45° field of view.
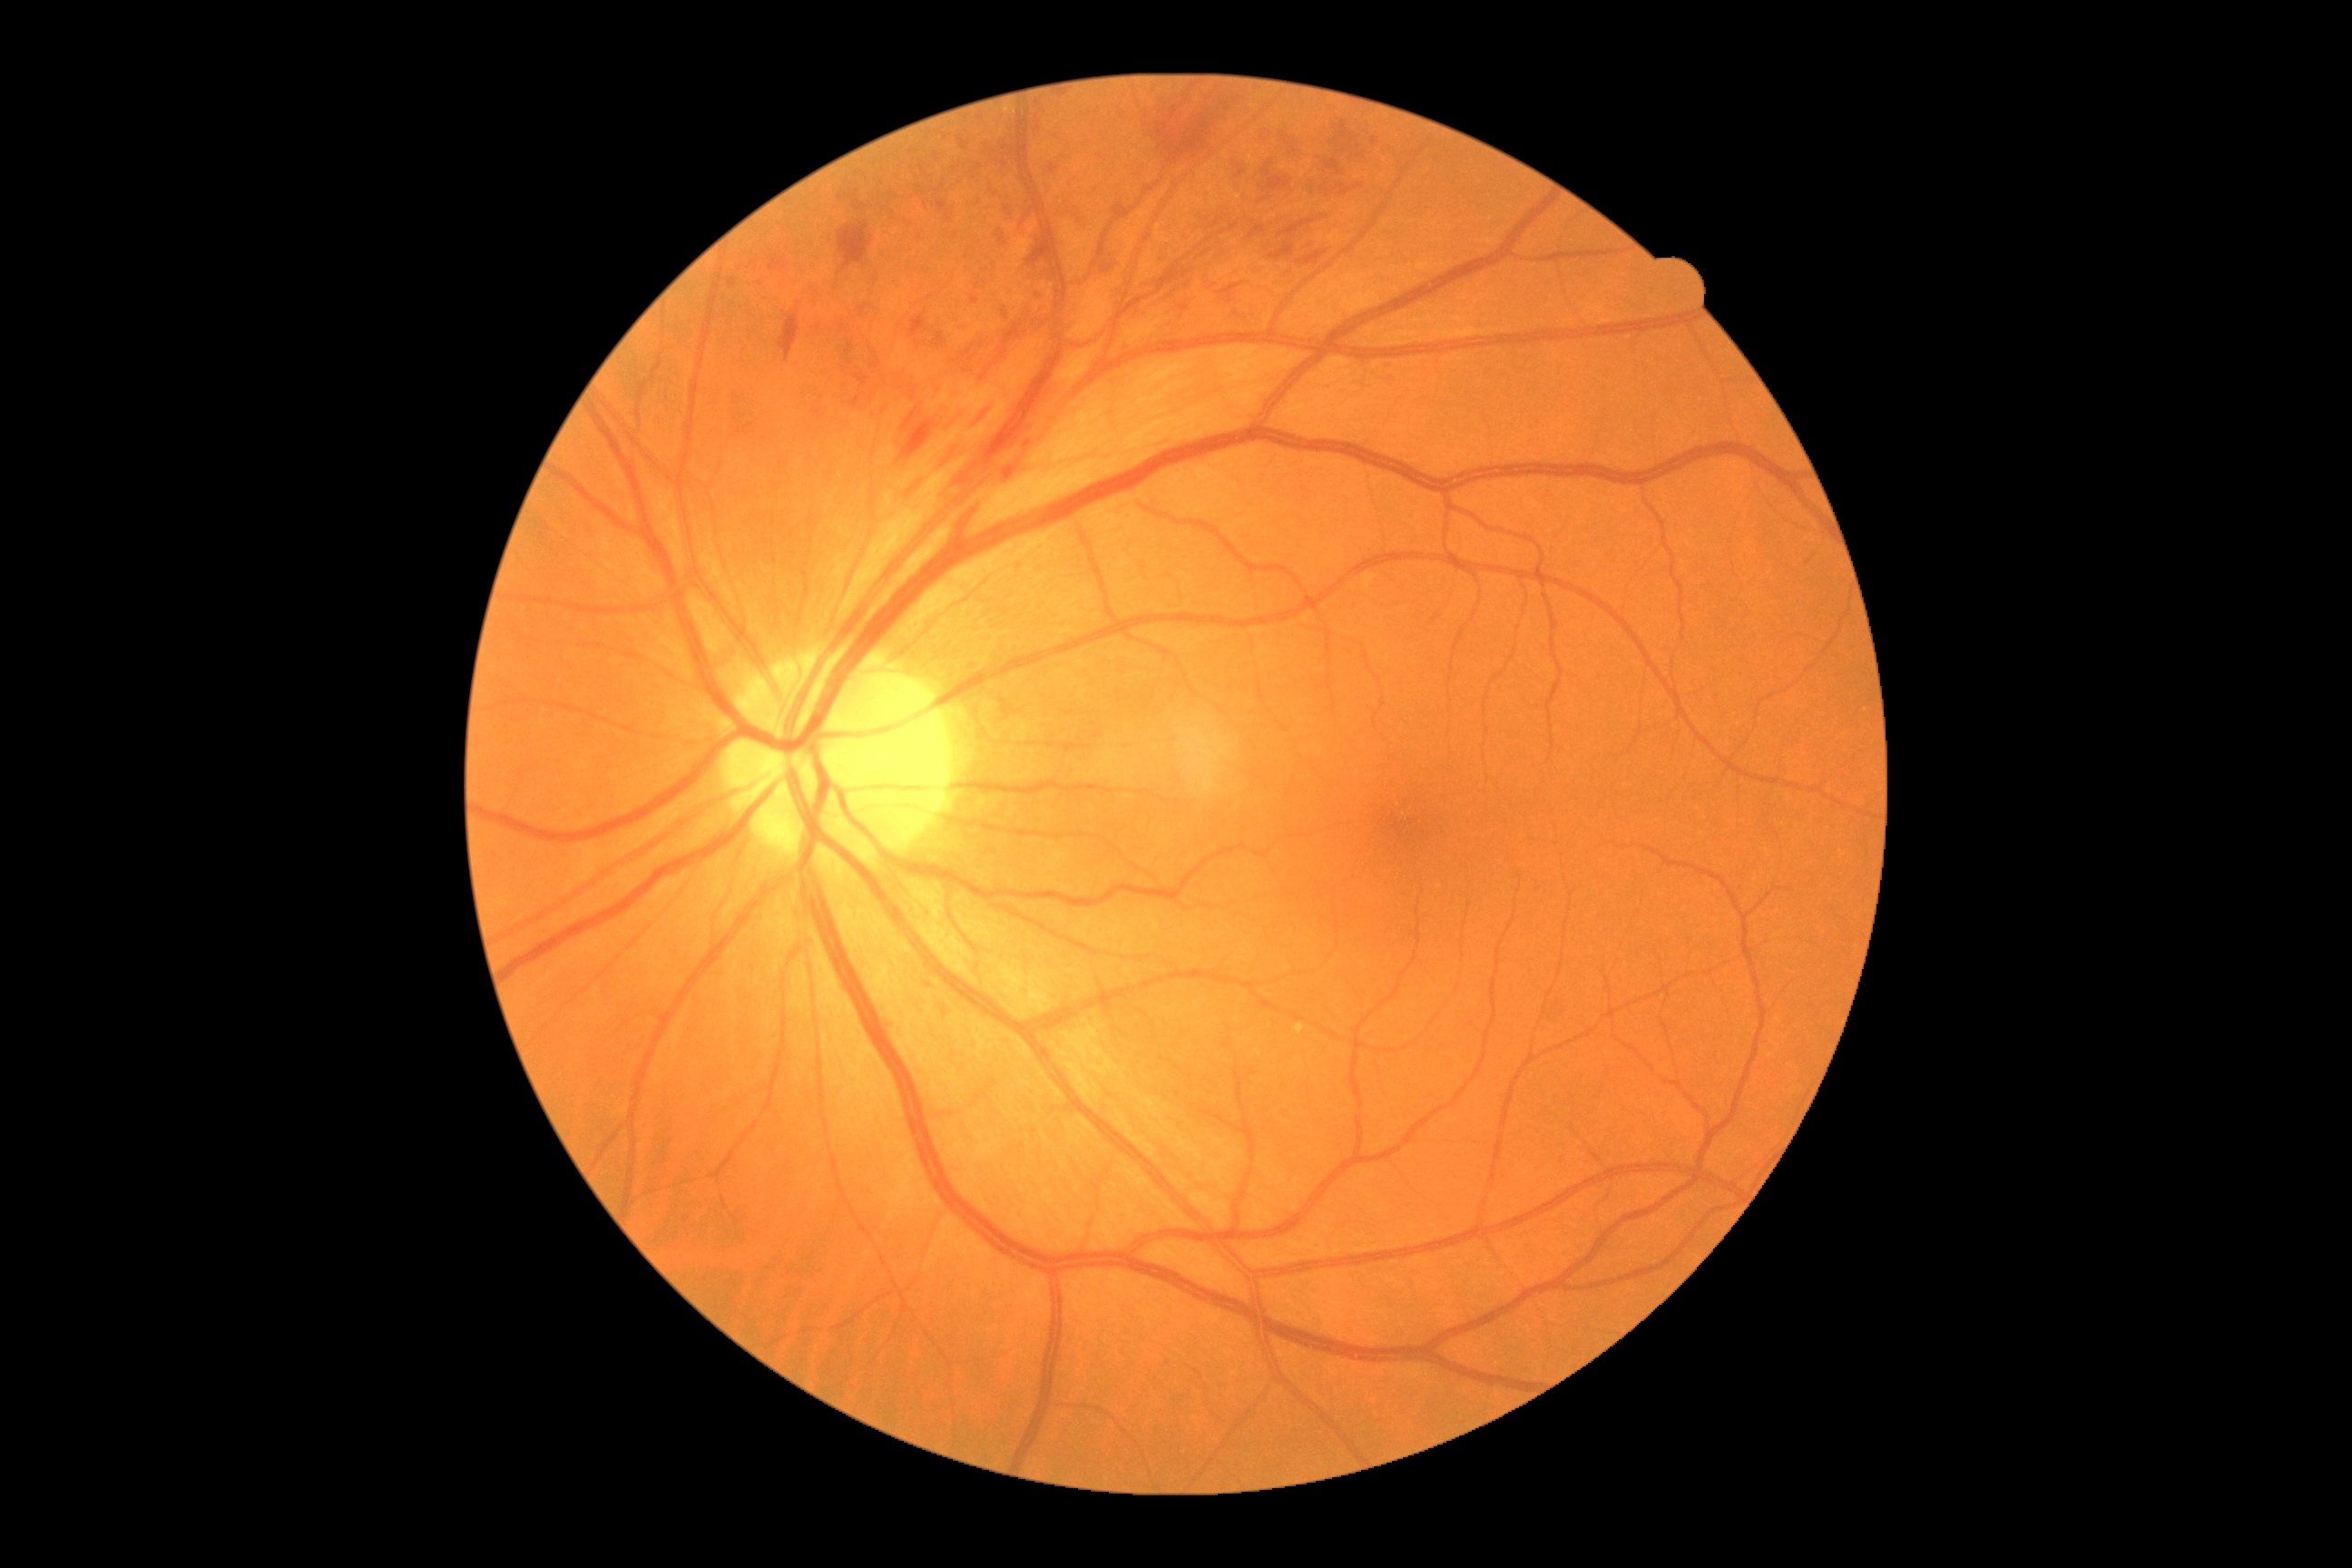 Diabetic retinopathy severity is moderate non-proliferative diabetic retinopathy (grade 2).